60-degree field of view, 2212x1659px
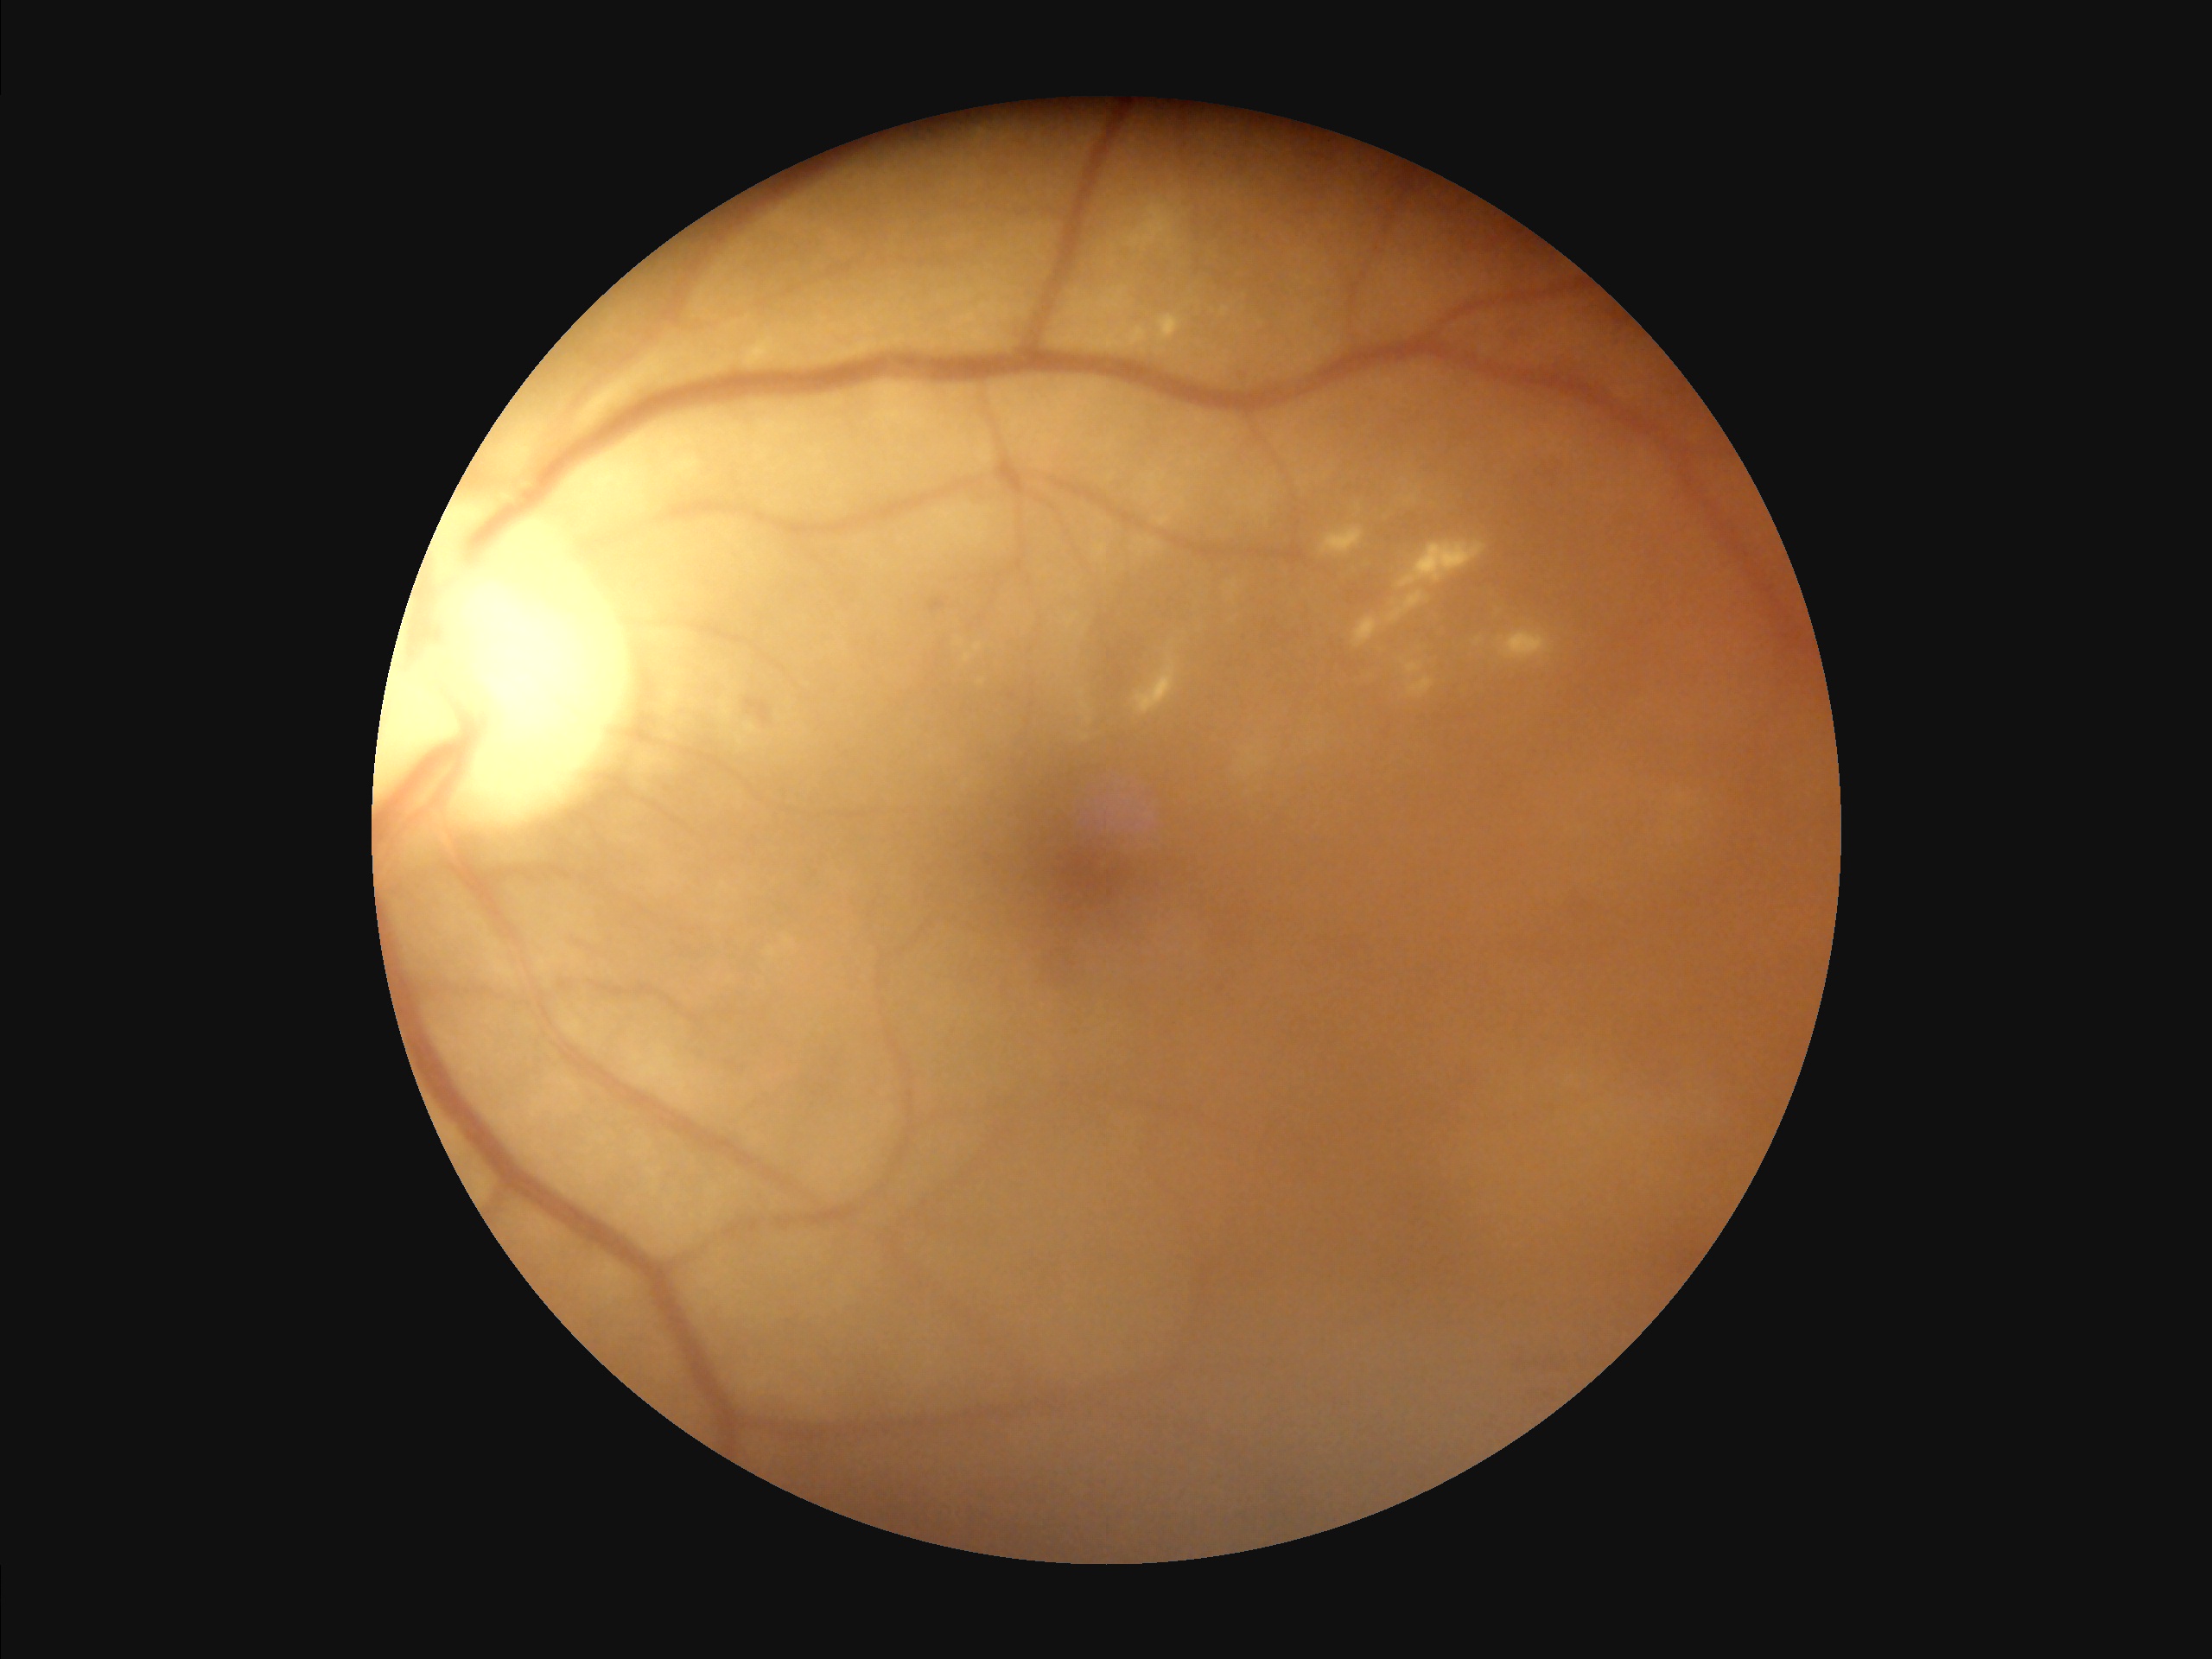

Overall image quality: inadequate for clinical interpretation
Illumination: no over- or under-exposure
Clarity: optic disc, vessels, and background in focus